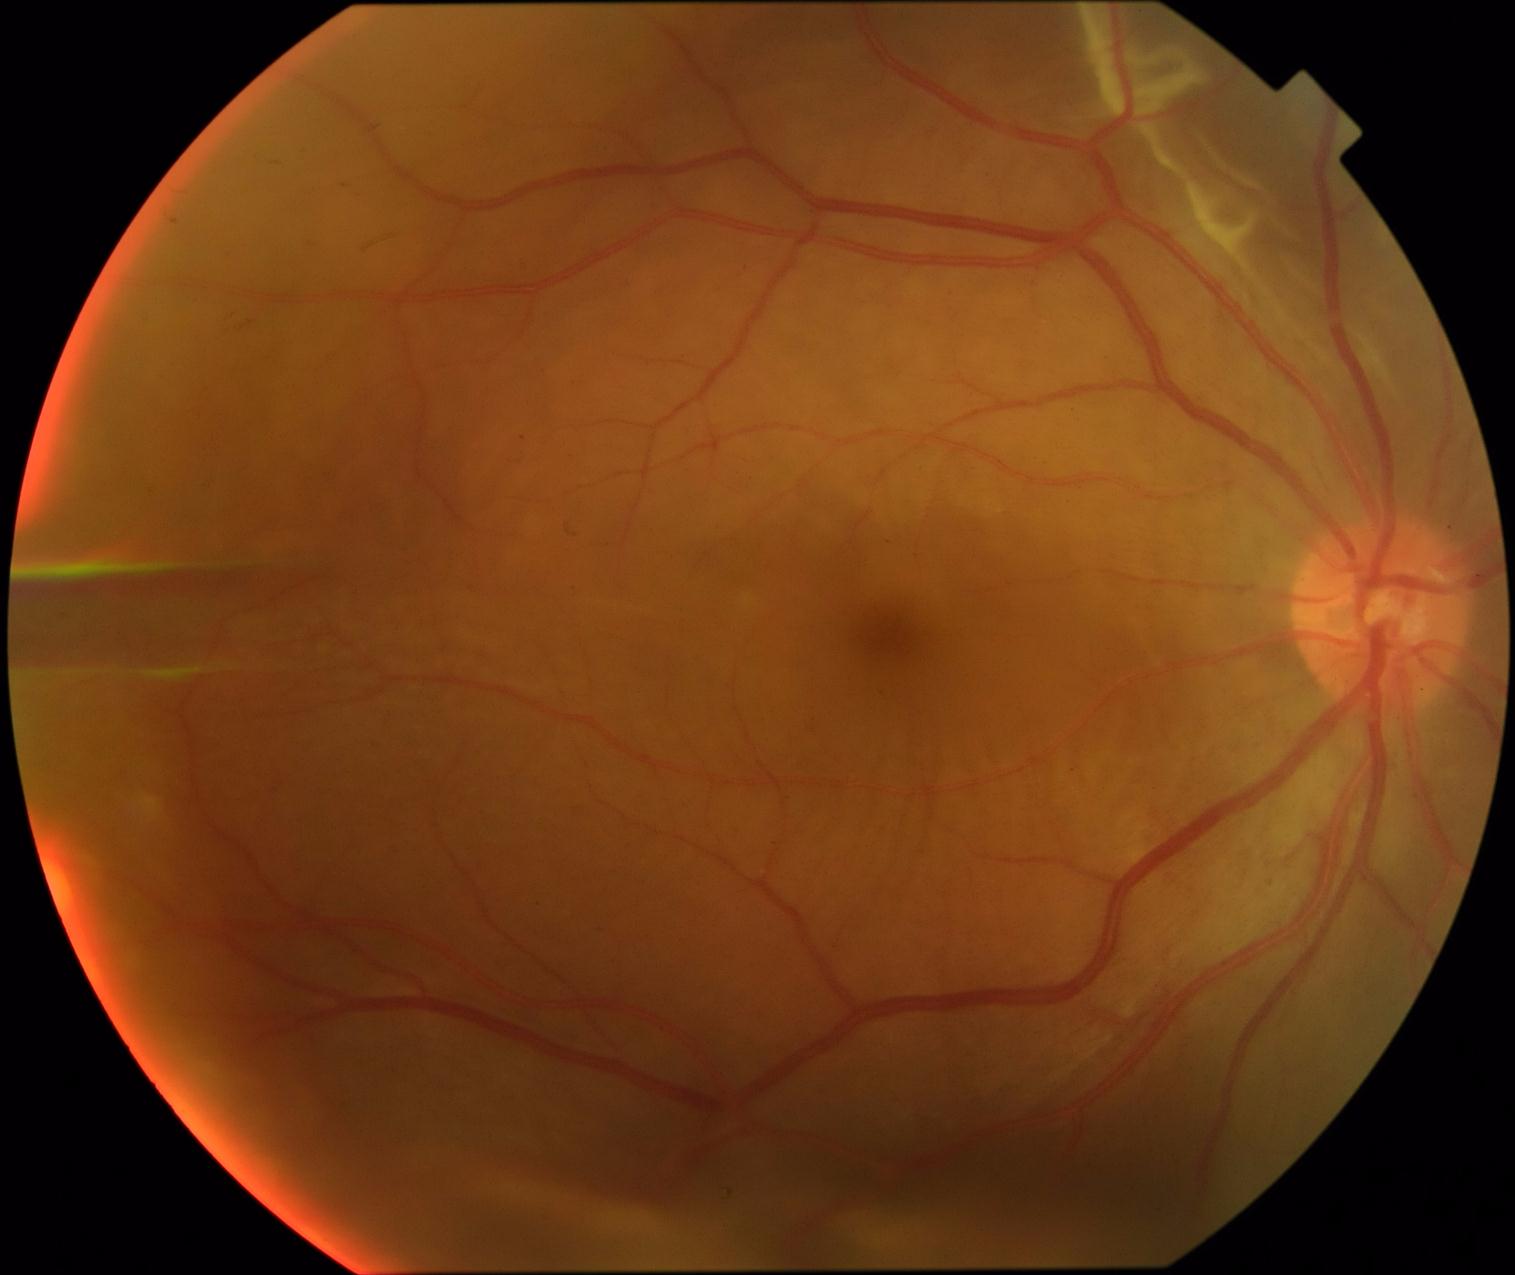
diabetic retinopathy grade=4.